Graded on the modified Davis scale.
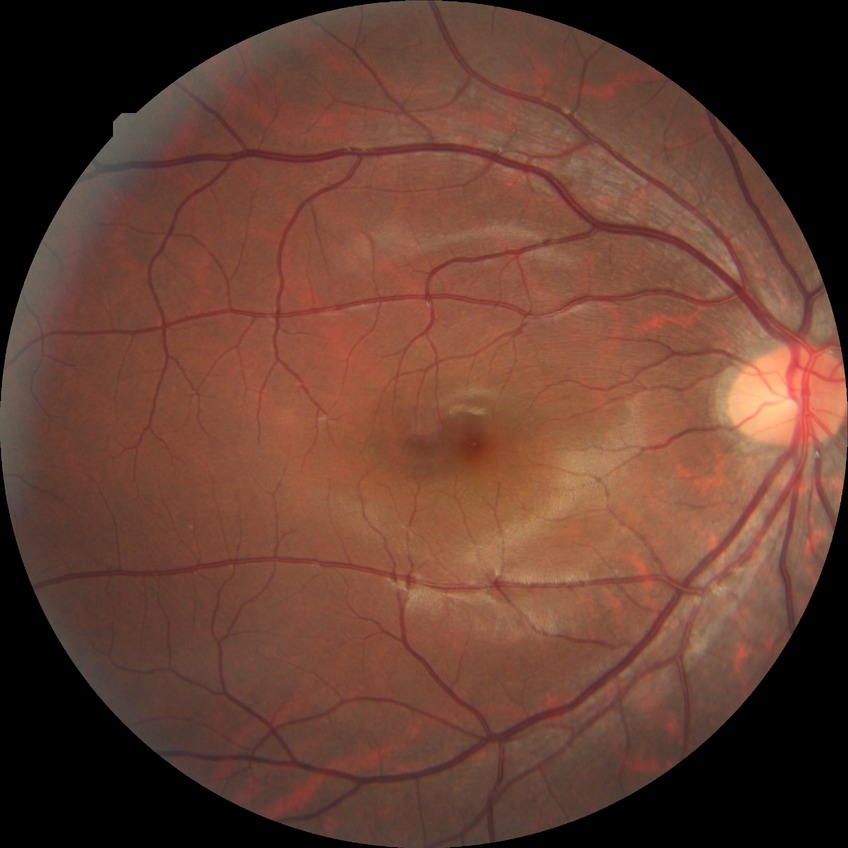

Modified Davis grade: NDR. No DR findings.